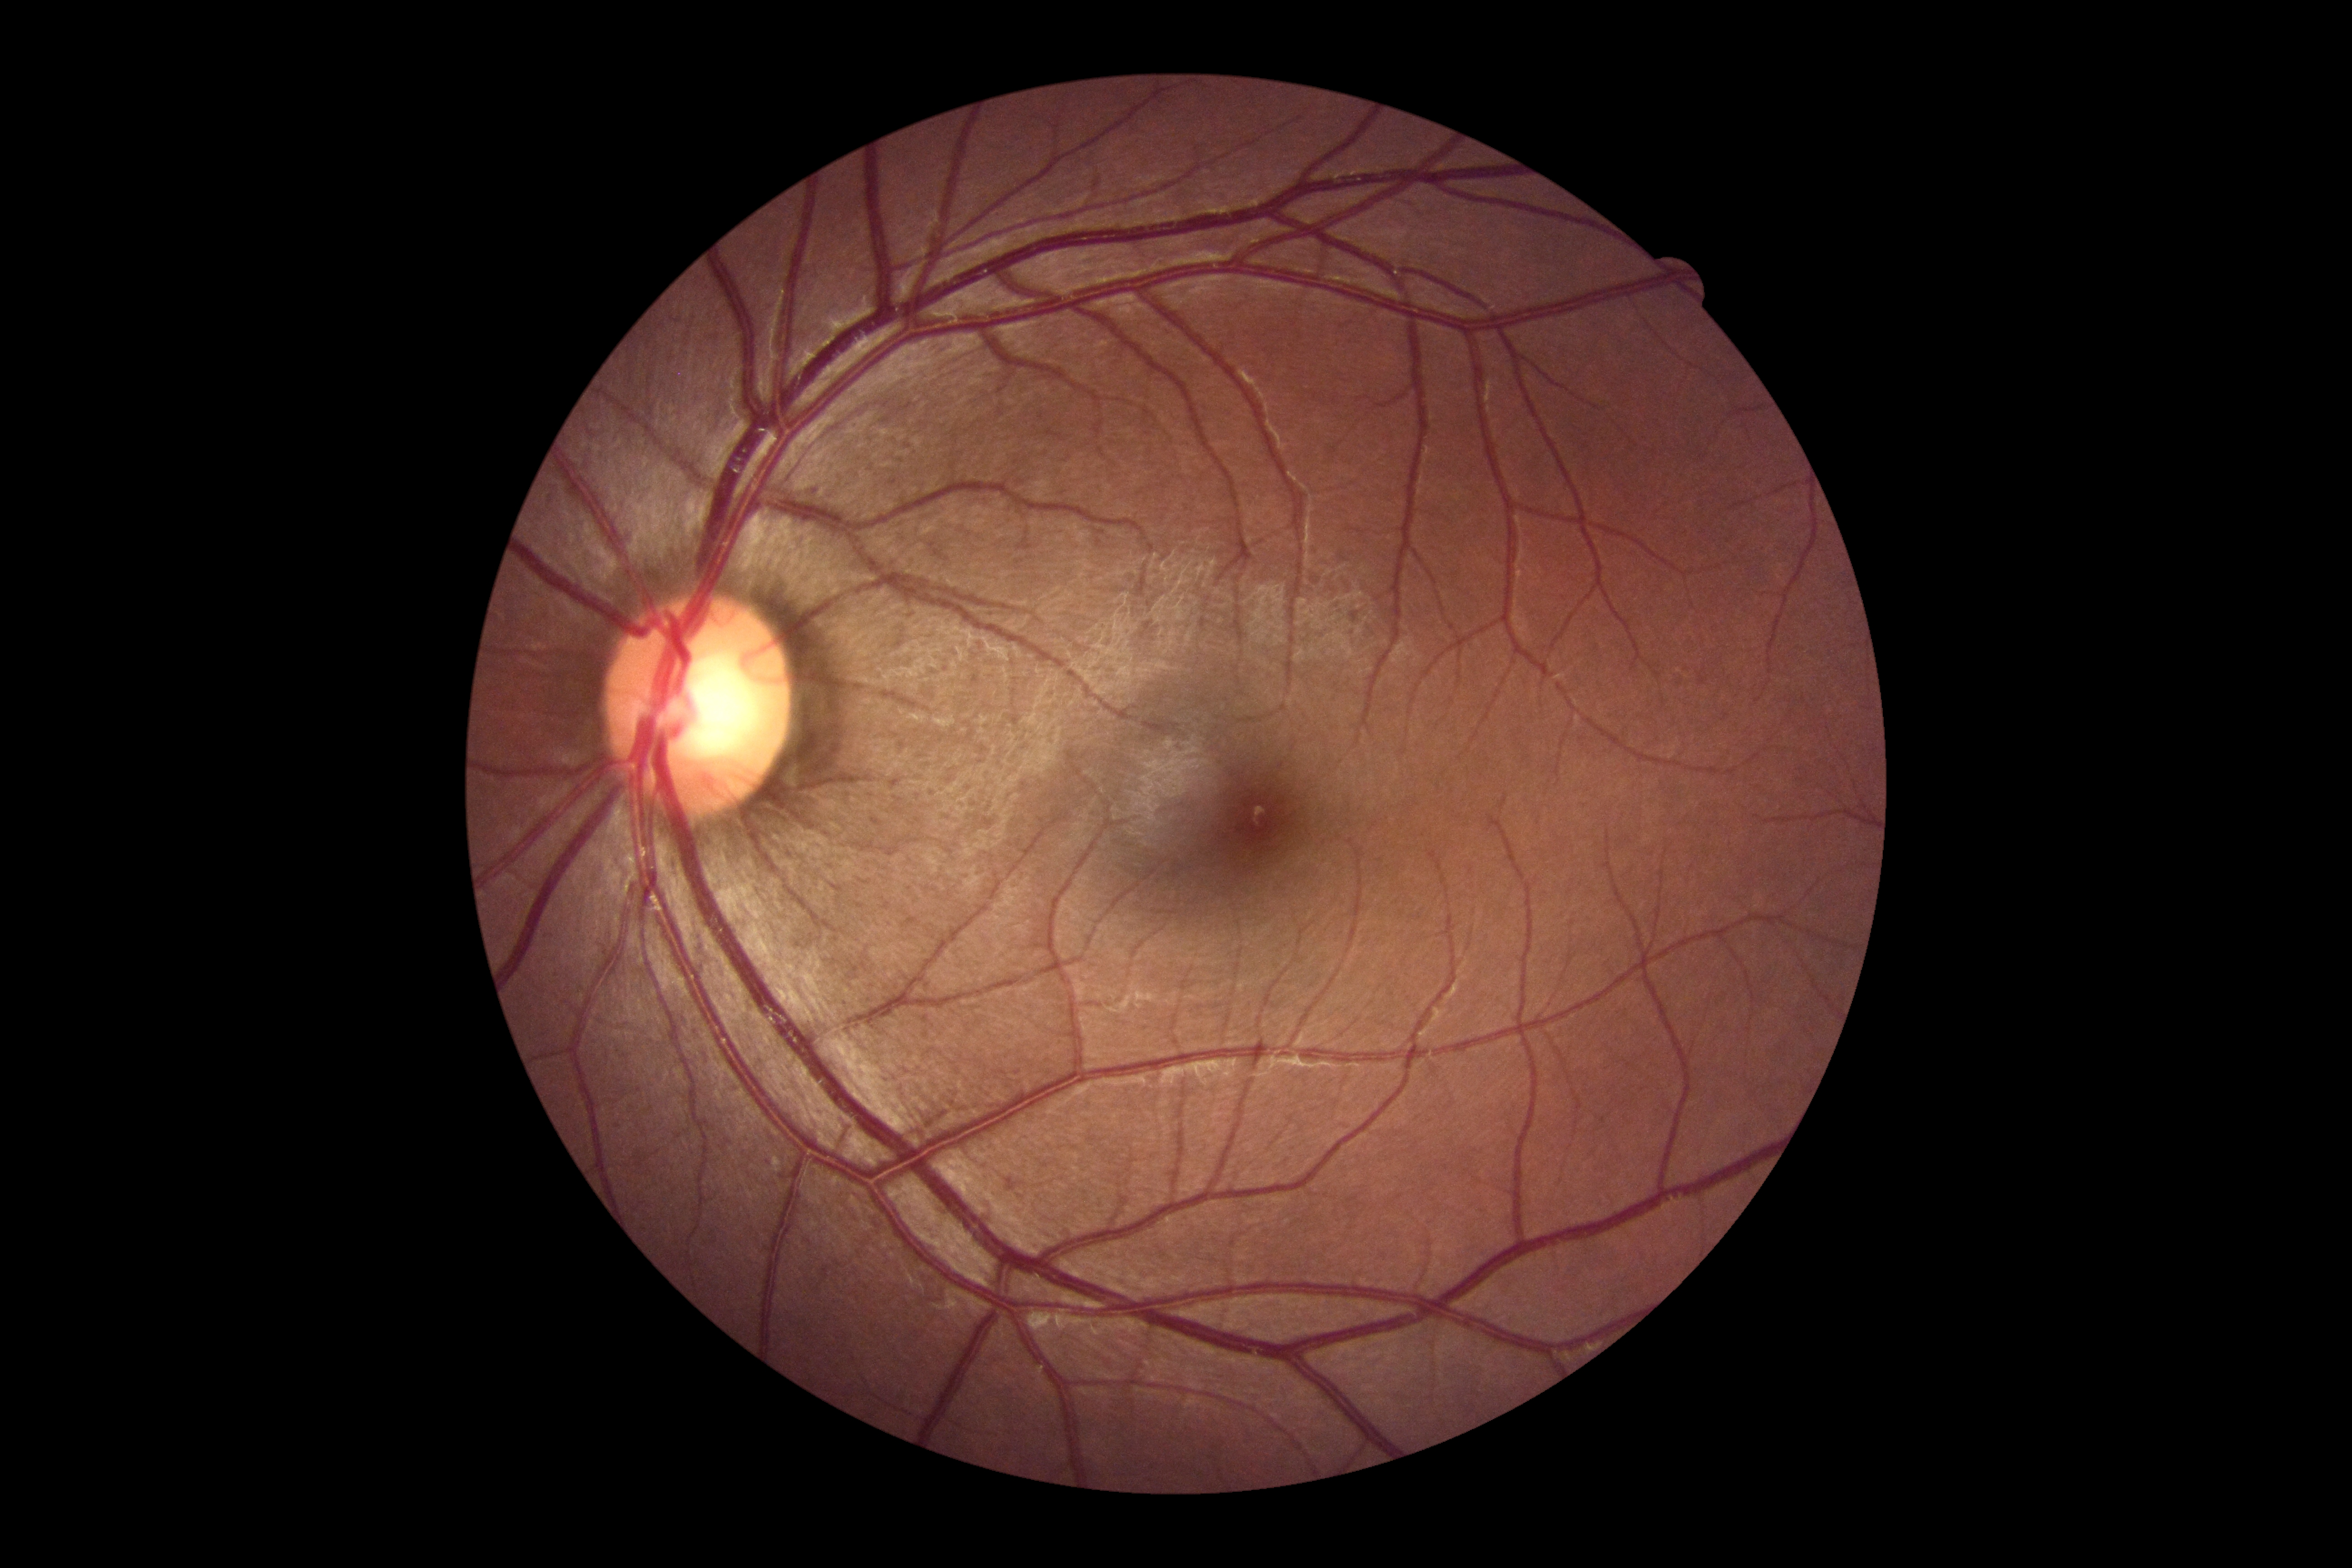 retinopathy grade: 0/4.